Acquired with a NIDEK AFC-230: 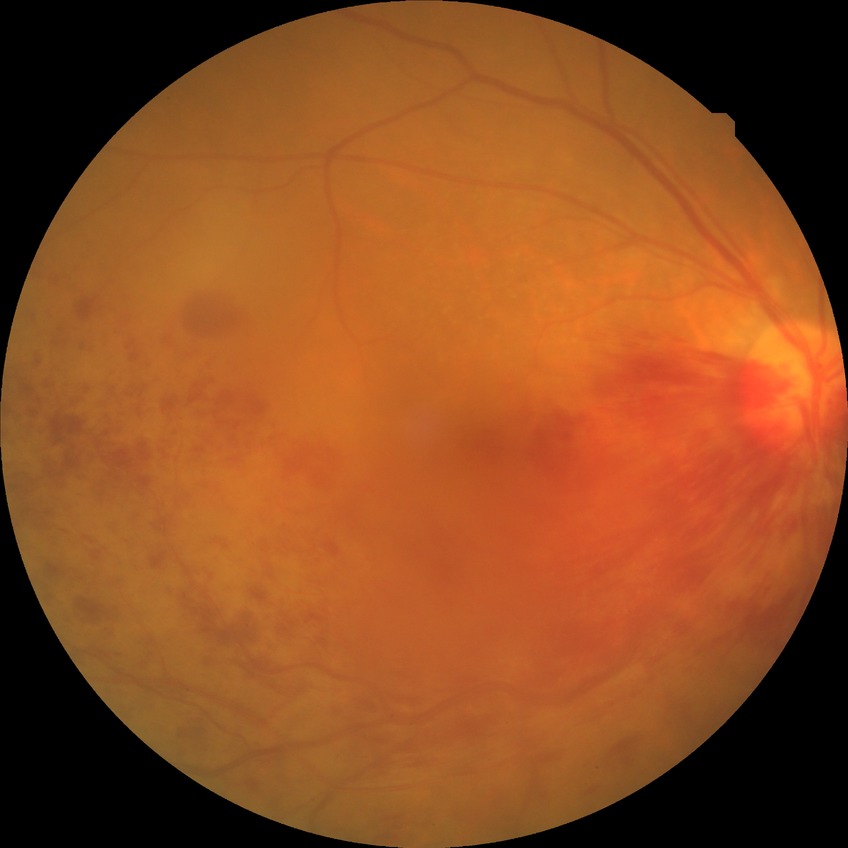 DR class: non-proliferative diabetic retinopathy. Diabetic retinopathy (DR): SDR (simple diabetic retinopathy).